Image size 2352x1568
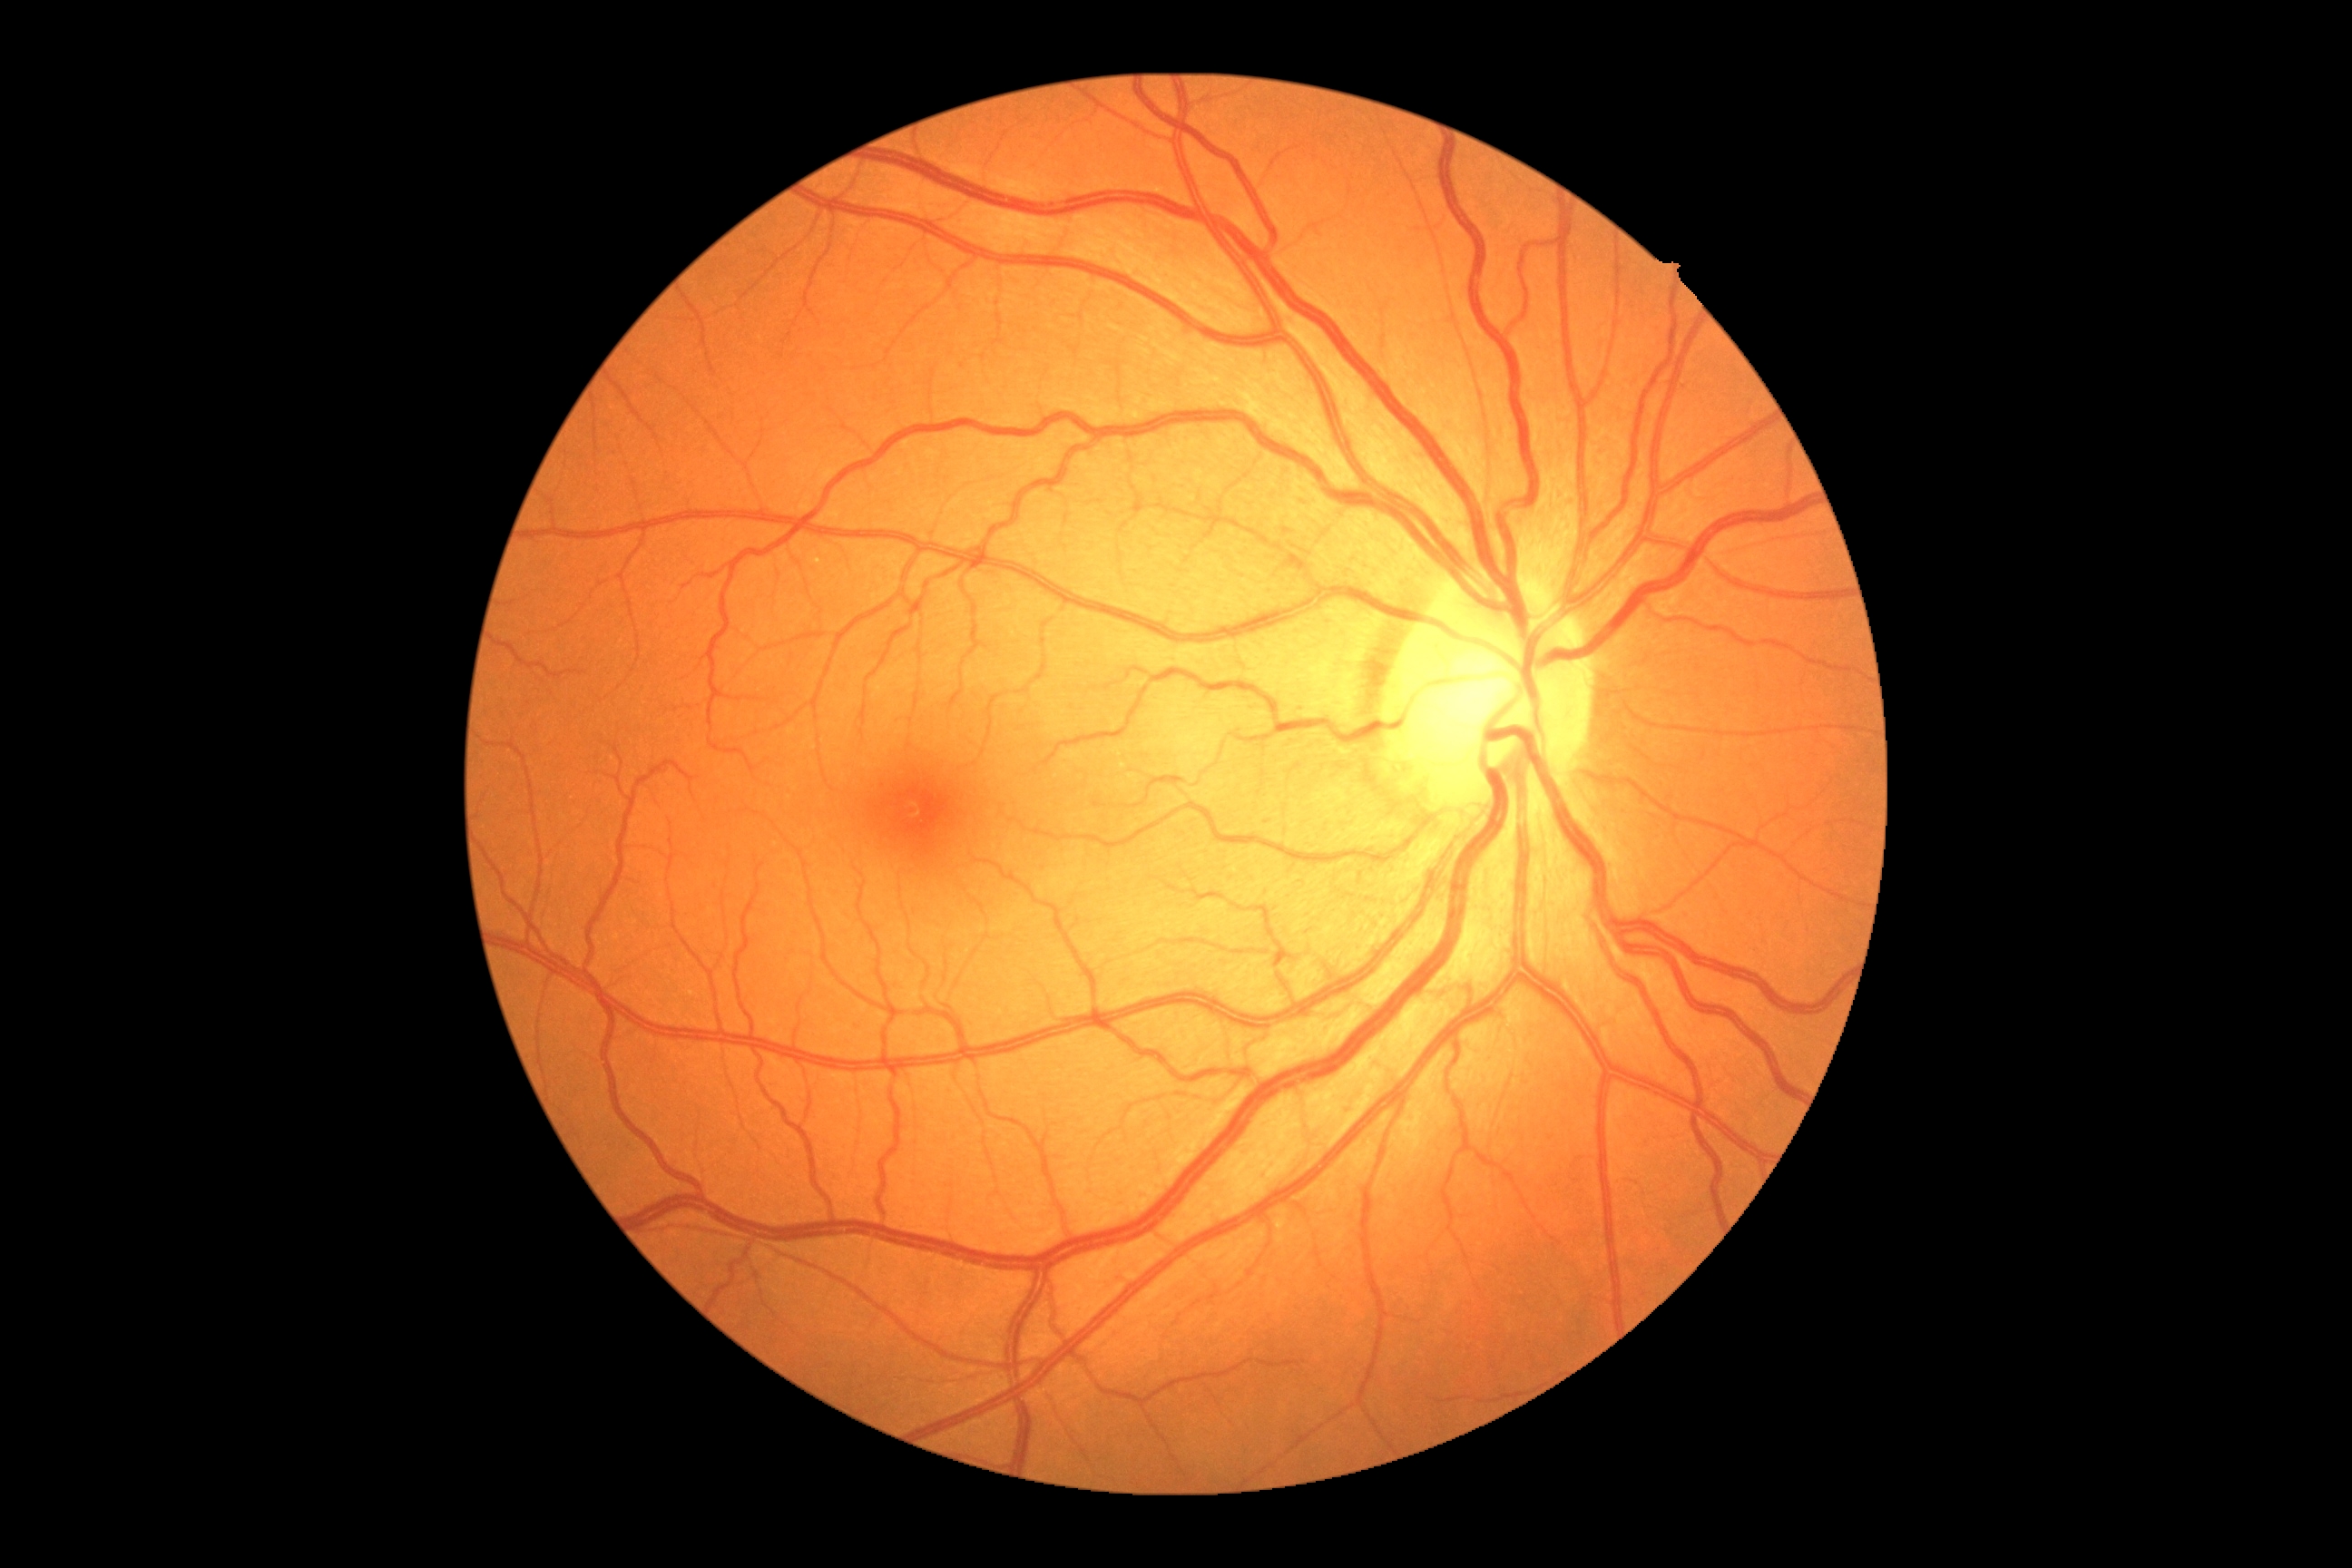

{"dr_grade": "no apparent diabetic retinopathy (grade 0)"}